Color fundus photograph:
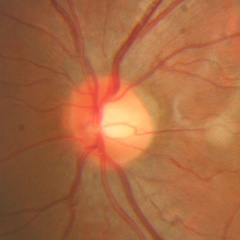

No glaucomatous changes.